Fundus photo, image size 1536x1152 — 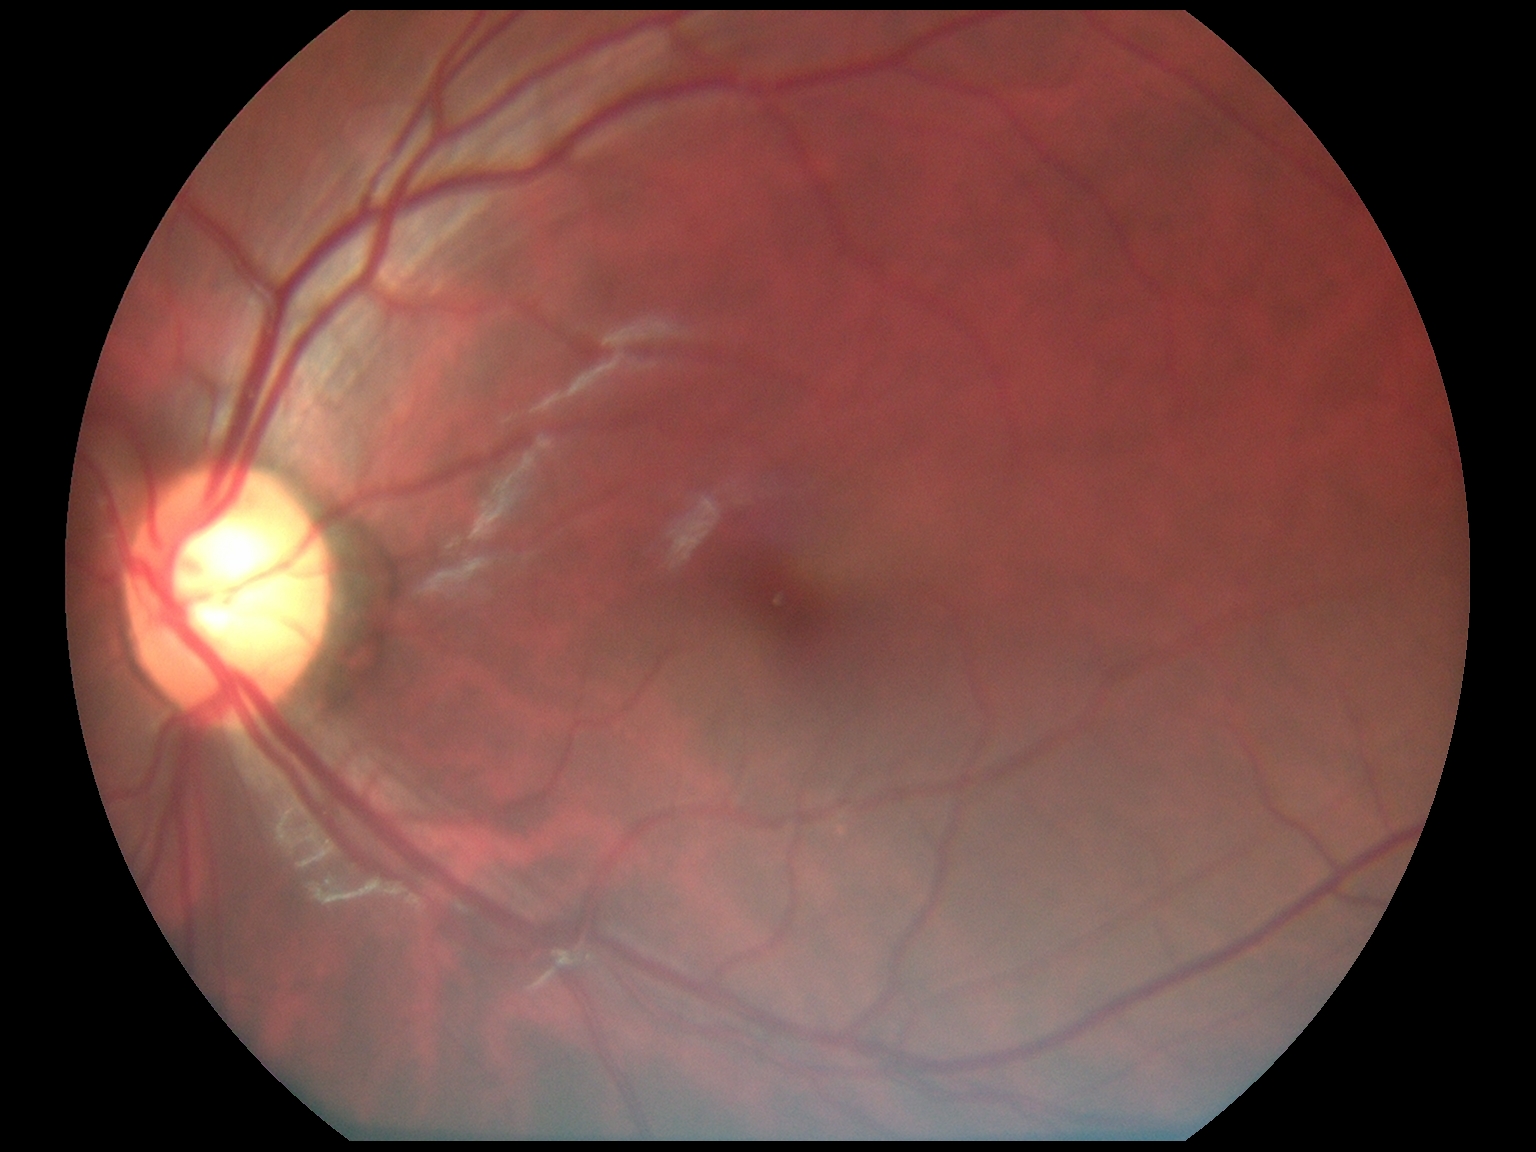
DR stage: grade 0 (no apparent retinopathy).